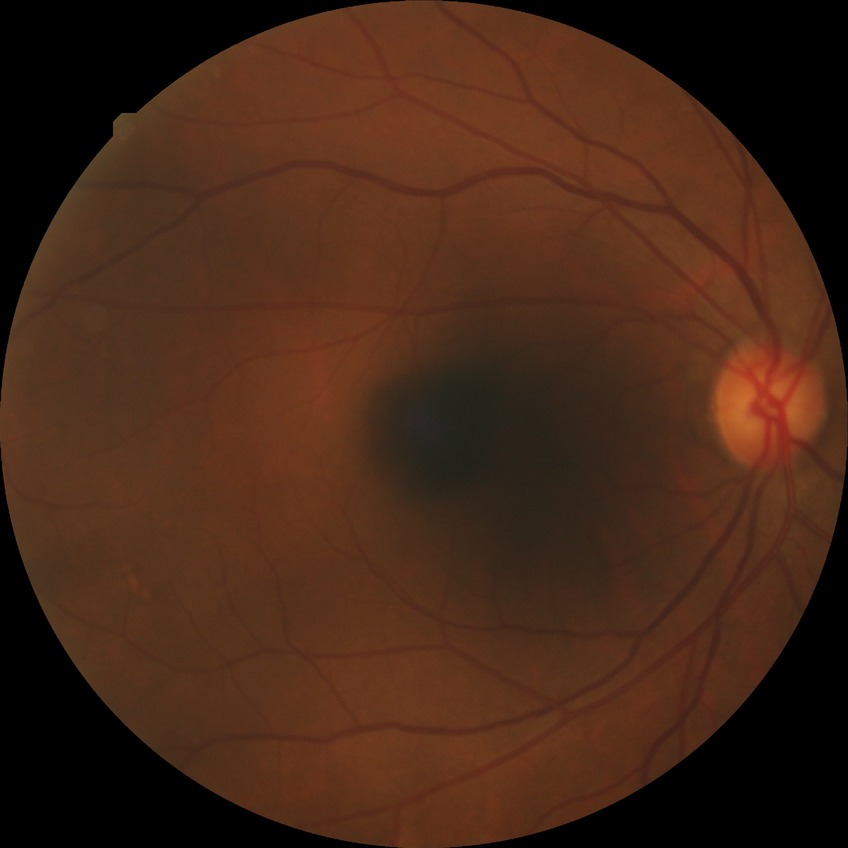 Retinopathy grade: no diabetic retinopathy.